Color fundus image: 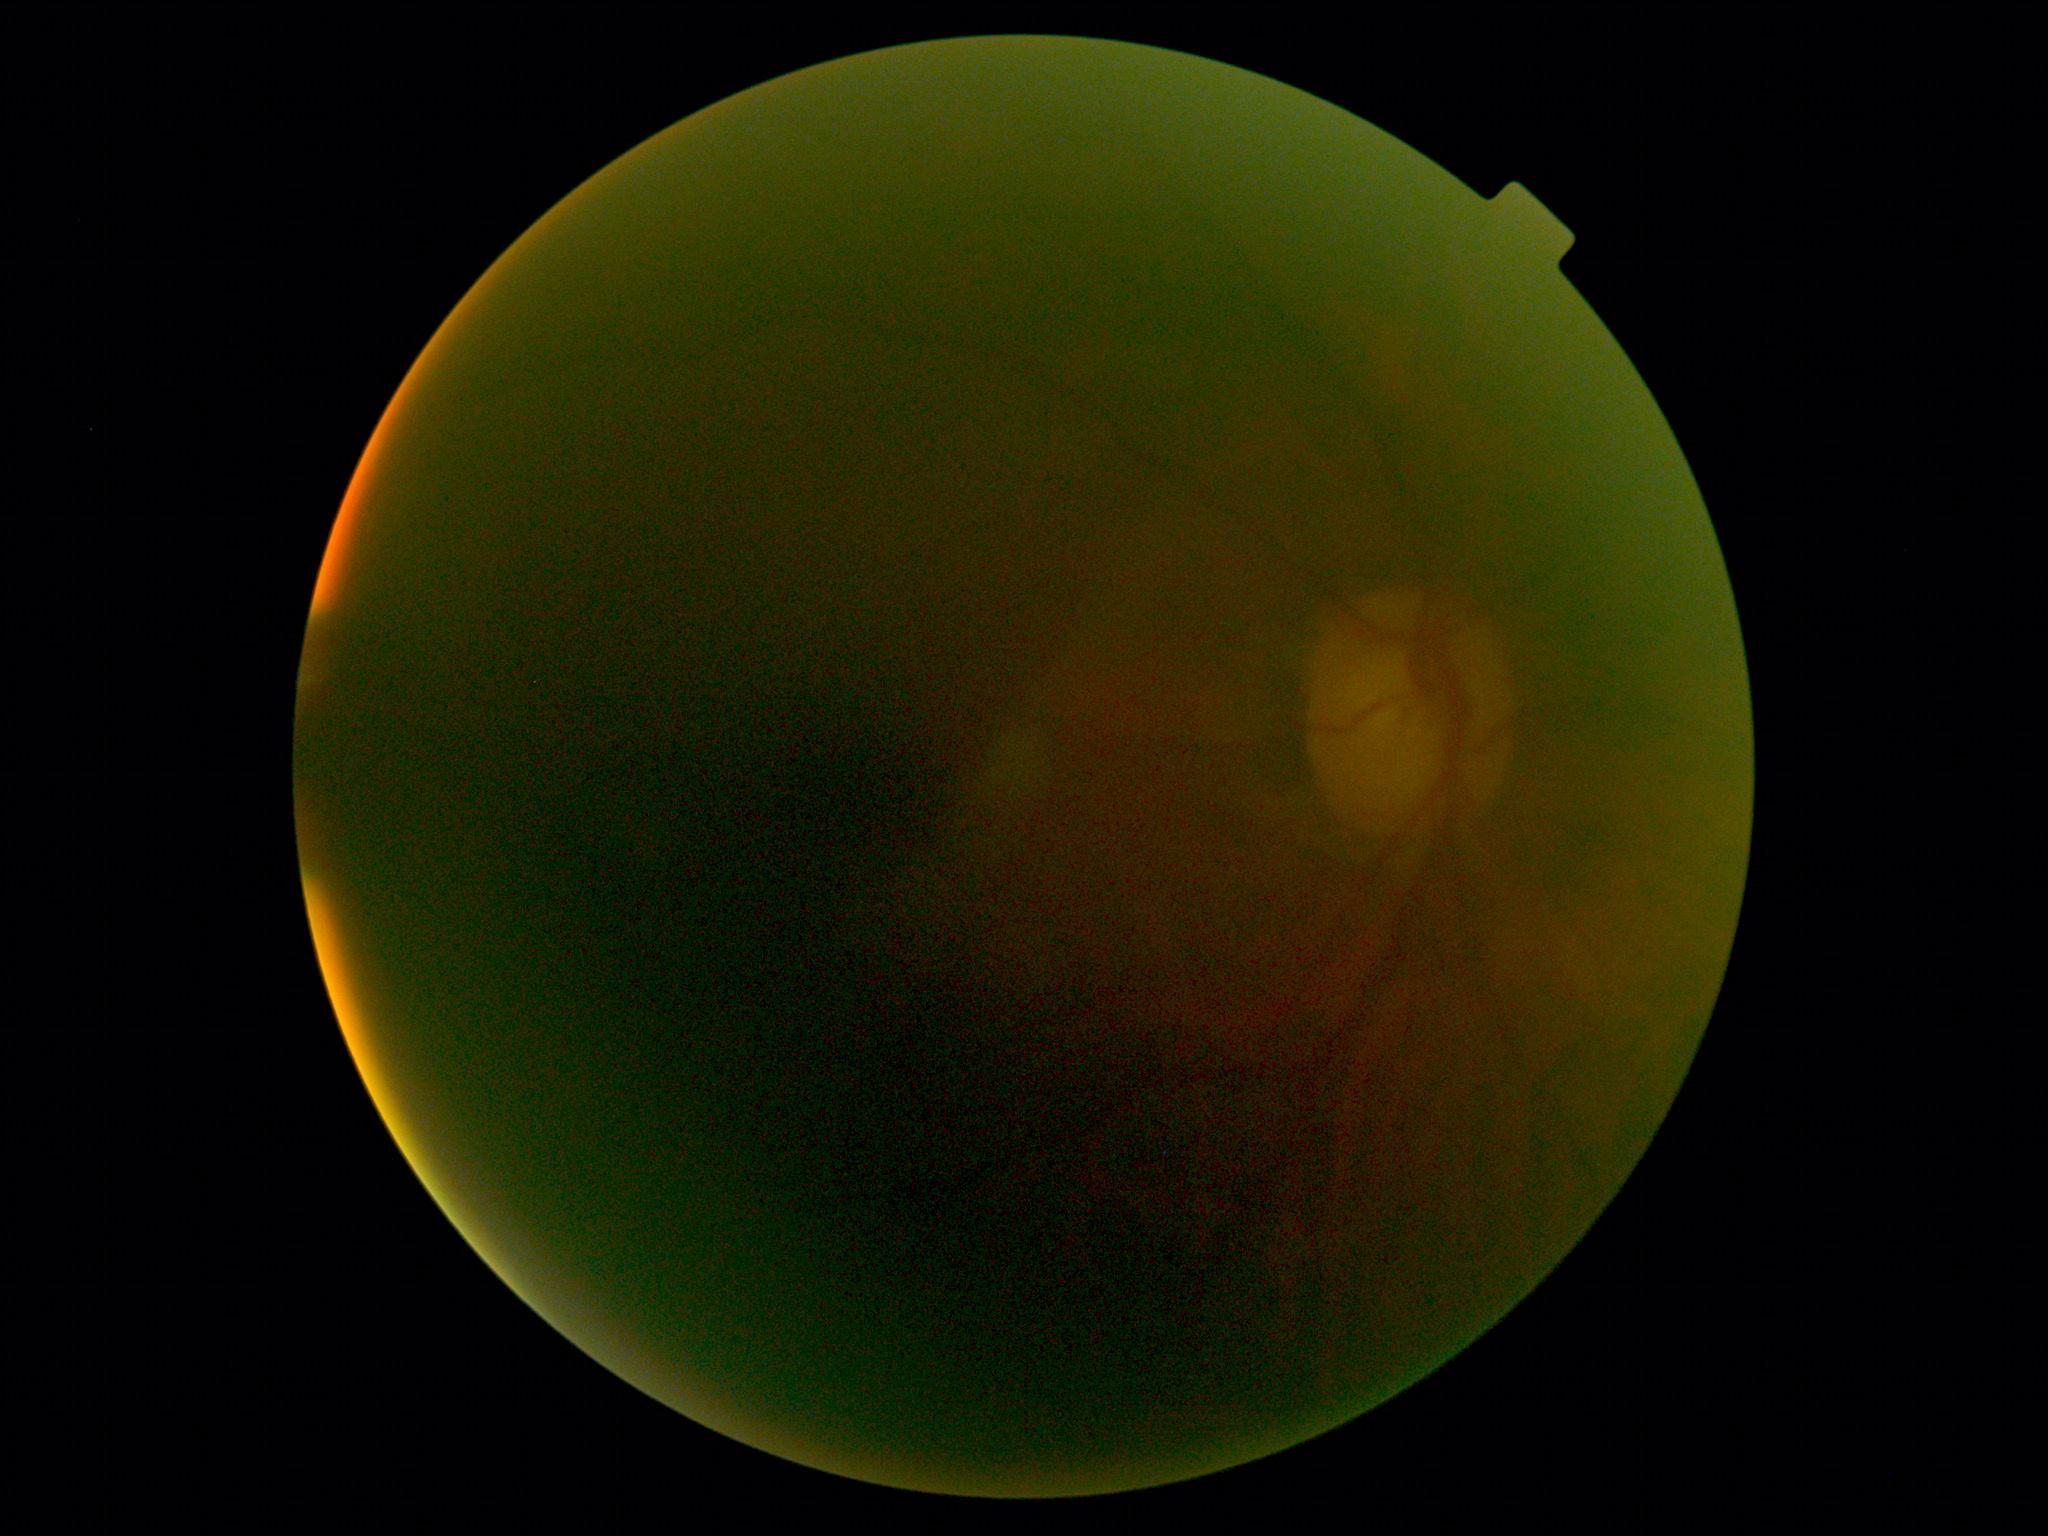

DR severity is ungradable.